848x848.
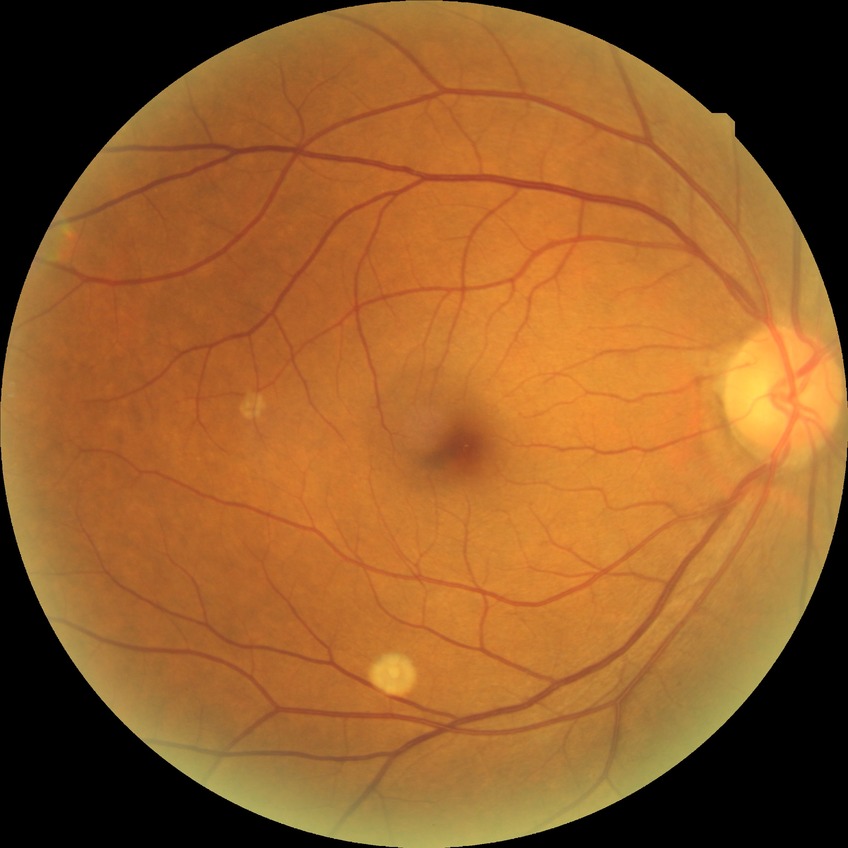 DR grade: NDR. No diabetic retinal disease findings.